Remidio FOP fundus camera
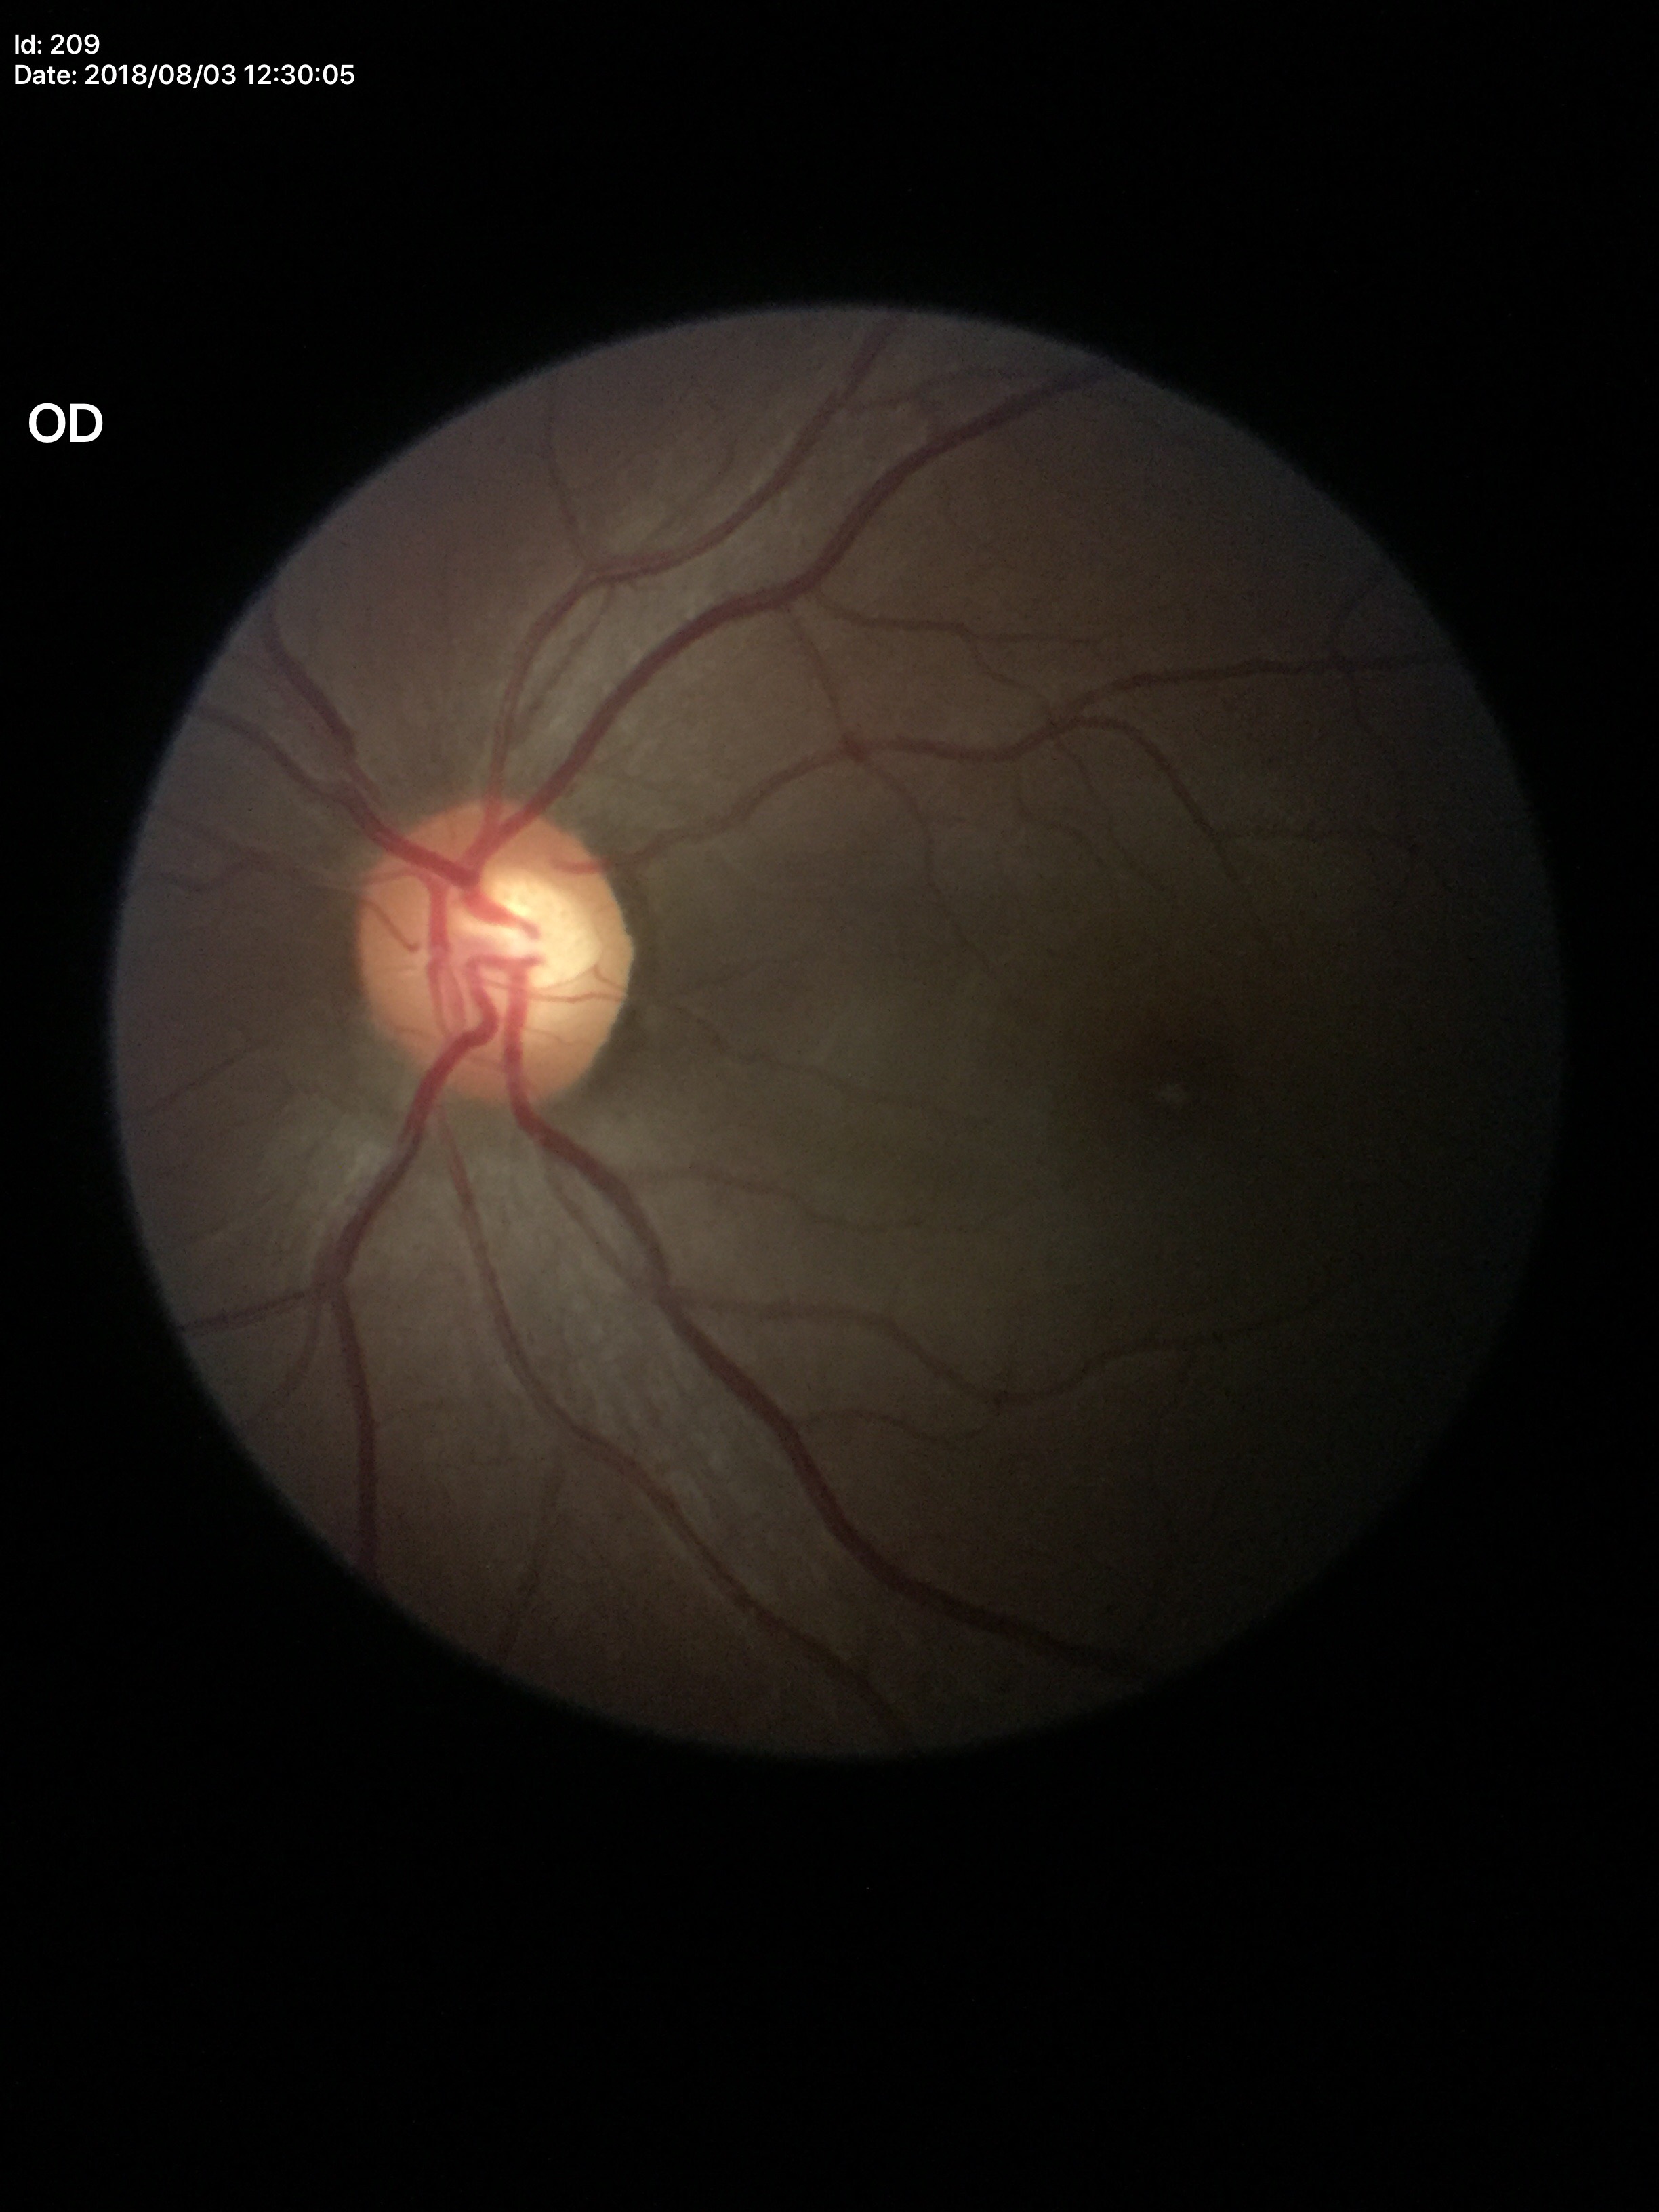 Glaucoma screening = negative, horizontal cup-to-disc ratio = 0.61, vertical C/D ratio = 0.58.